Color fundus image: 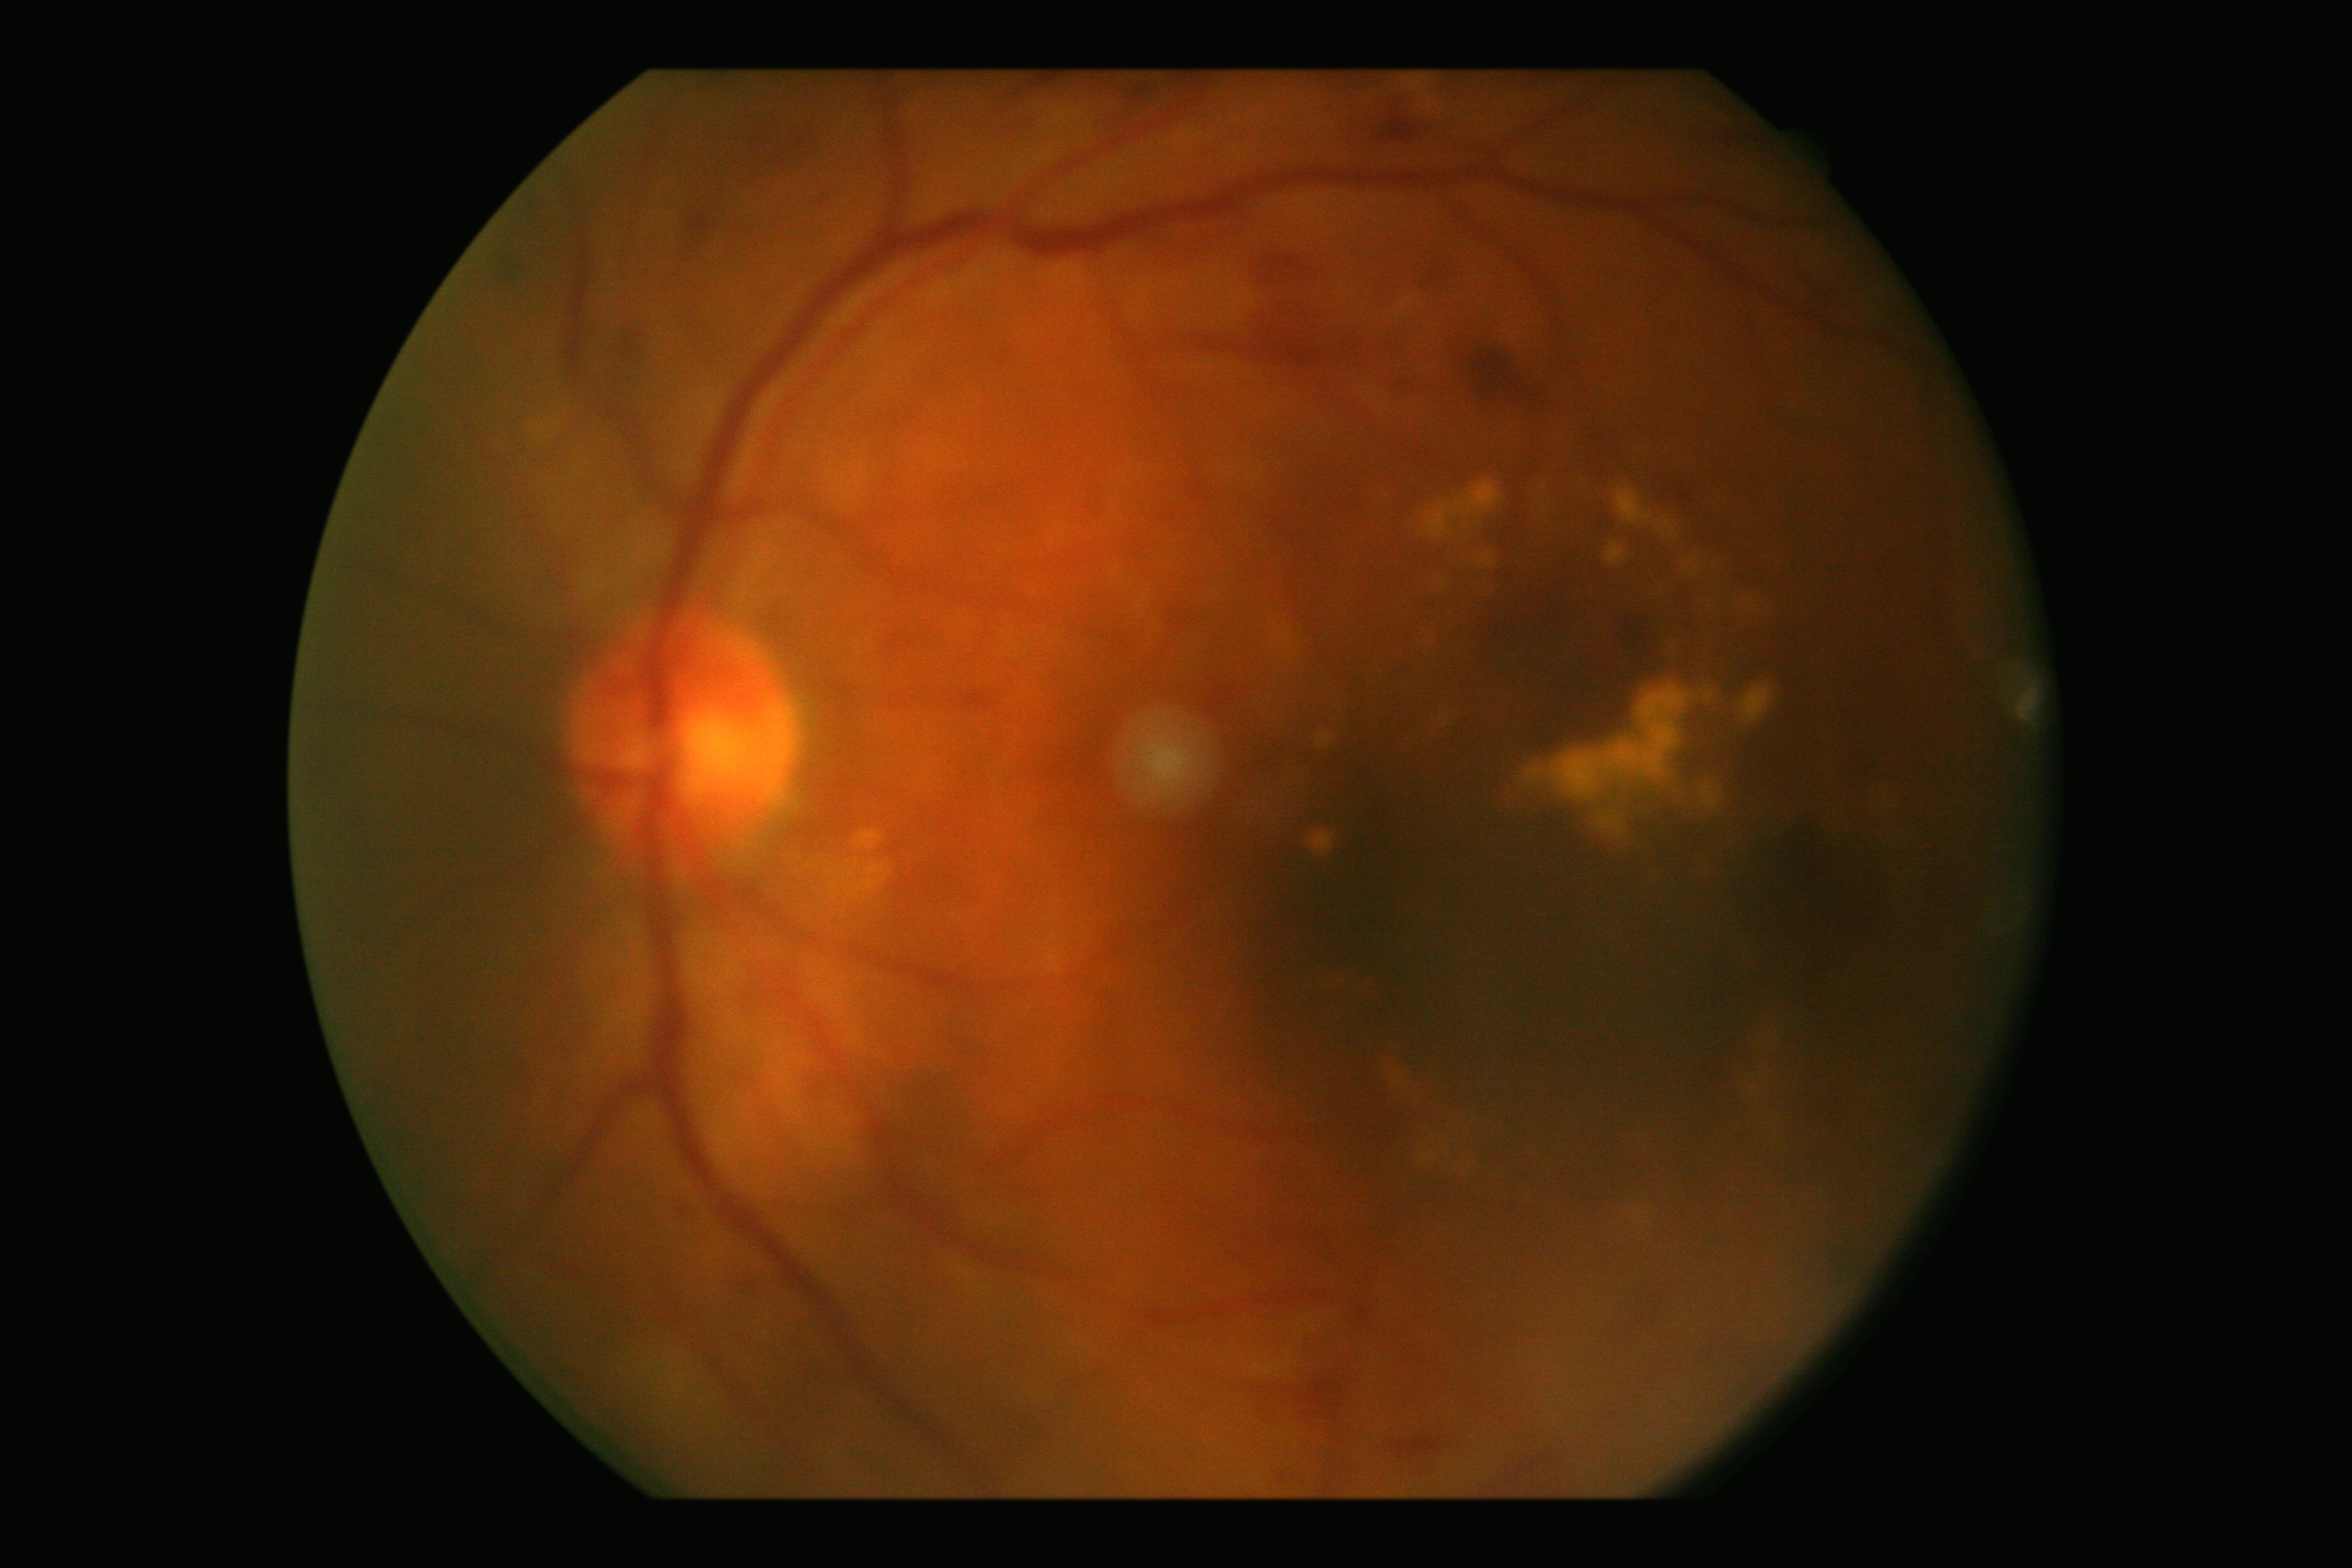 DR: grade 2 — more than just microaneurysms but less than severe NPDR.